45° FOV. No pharmacologic dilation — 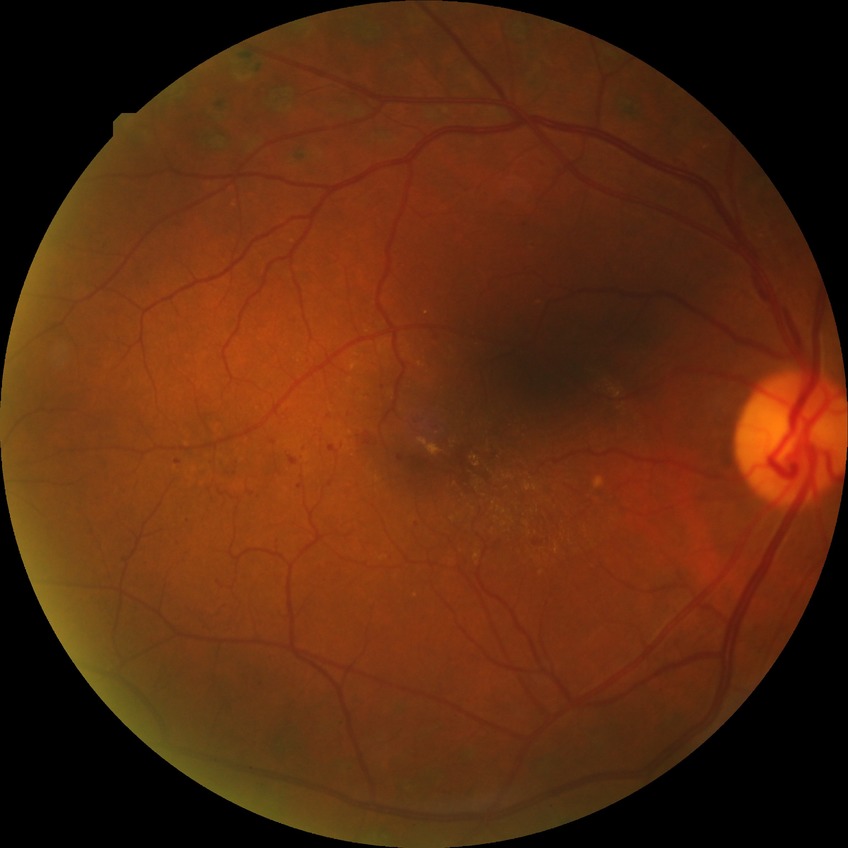
Diabetic retinopathy (DR) is proliferative diabetic retinopathy (PDR).